848x848px · nonmydriatic · diabetic retinopathy graded by the modified Davis classification · 45° field of view — 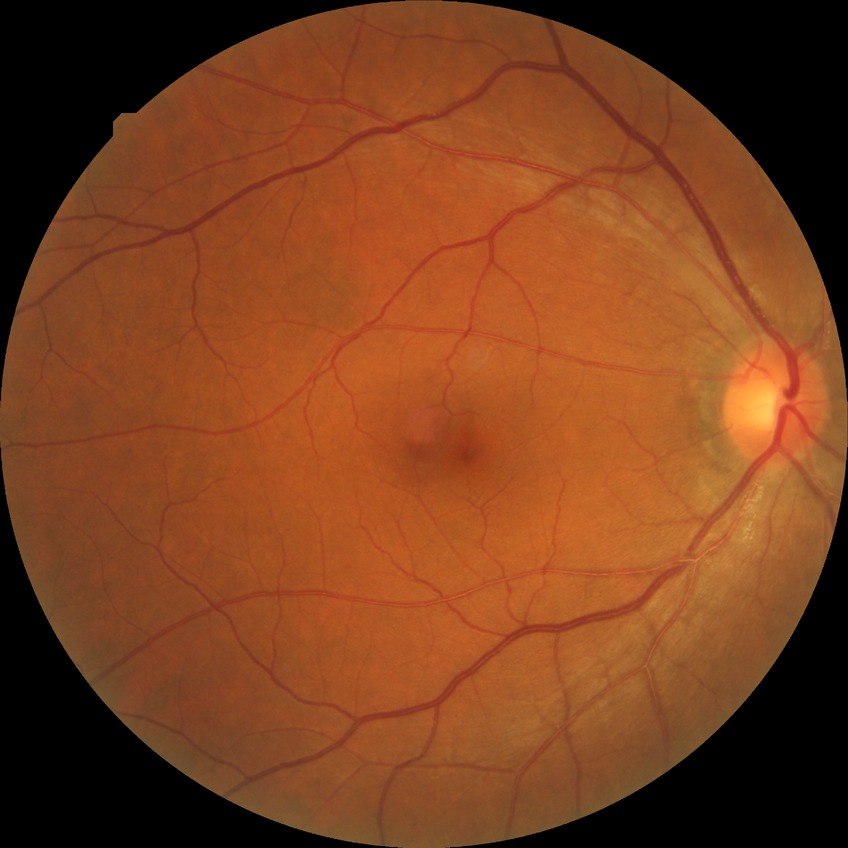
Diabetic retinopathy (DR): no diabetic retinopathy (NDR).